Graded on the modified Davis scale — 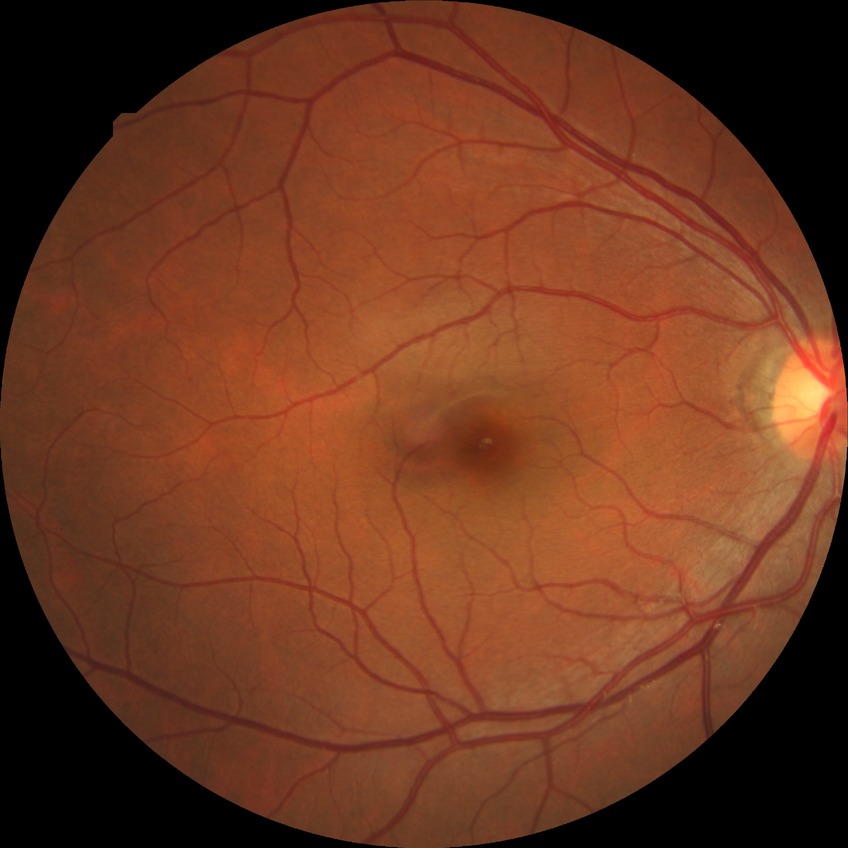

No DR findings. Modified Davis grade: NDR.